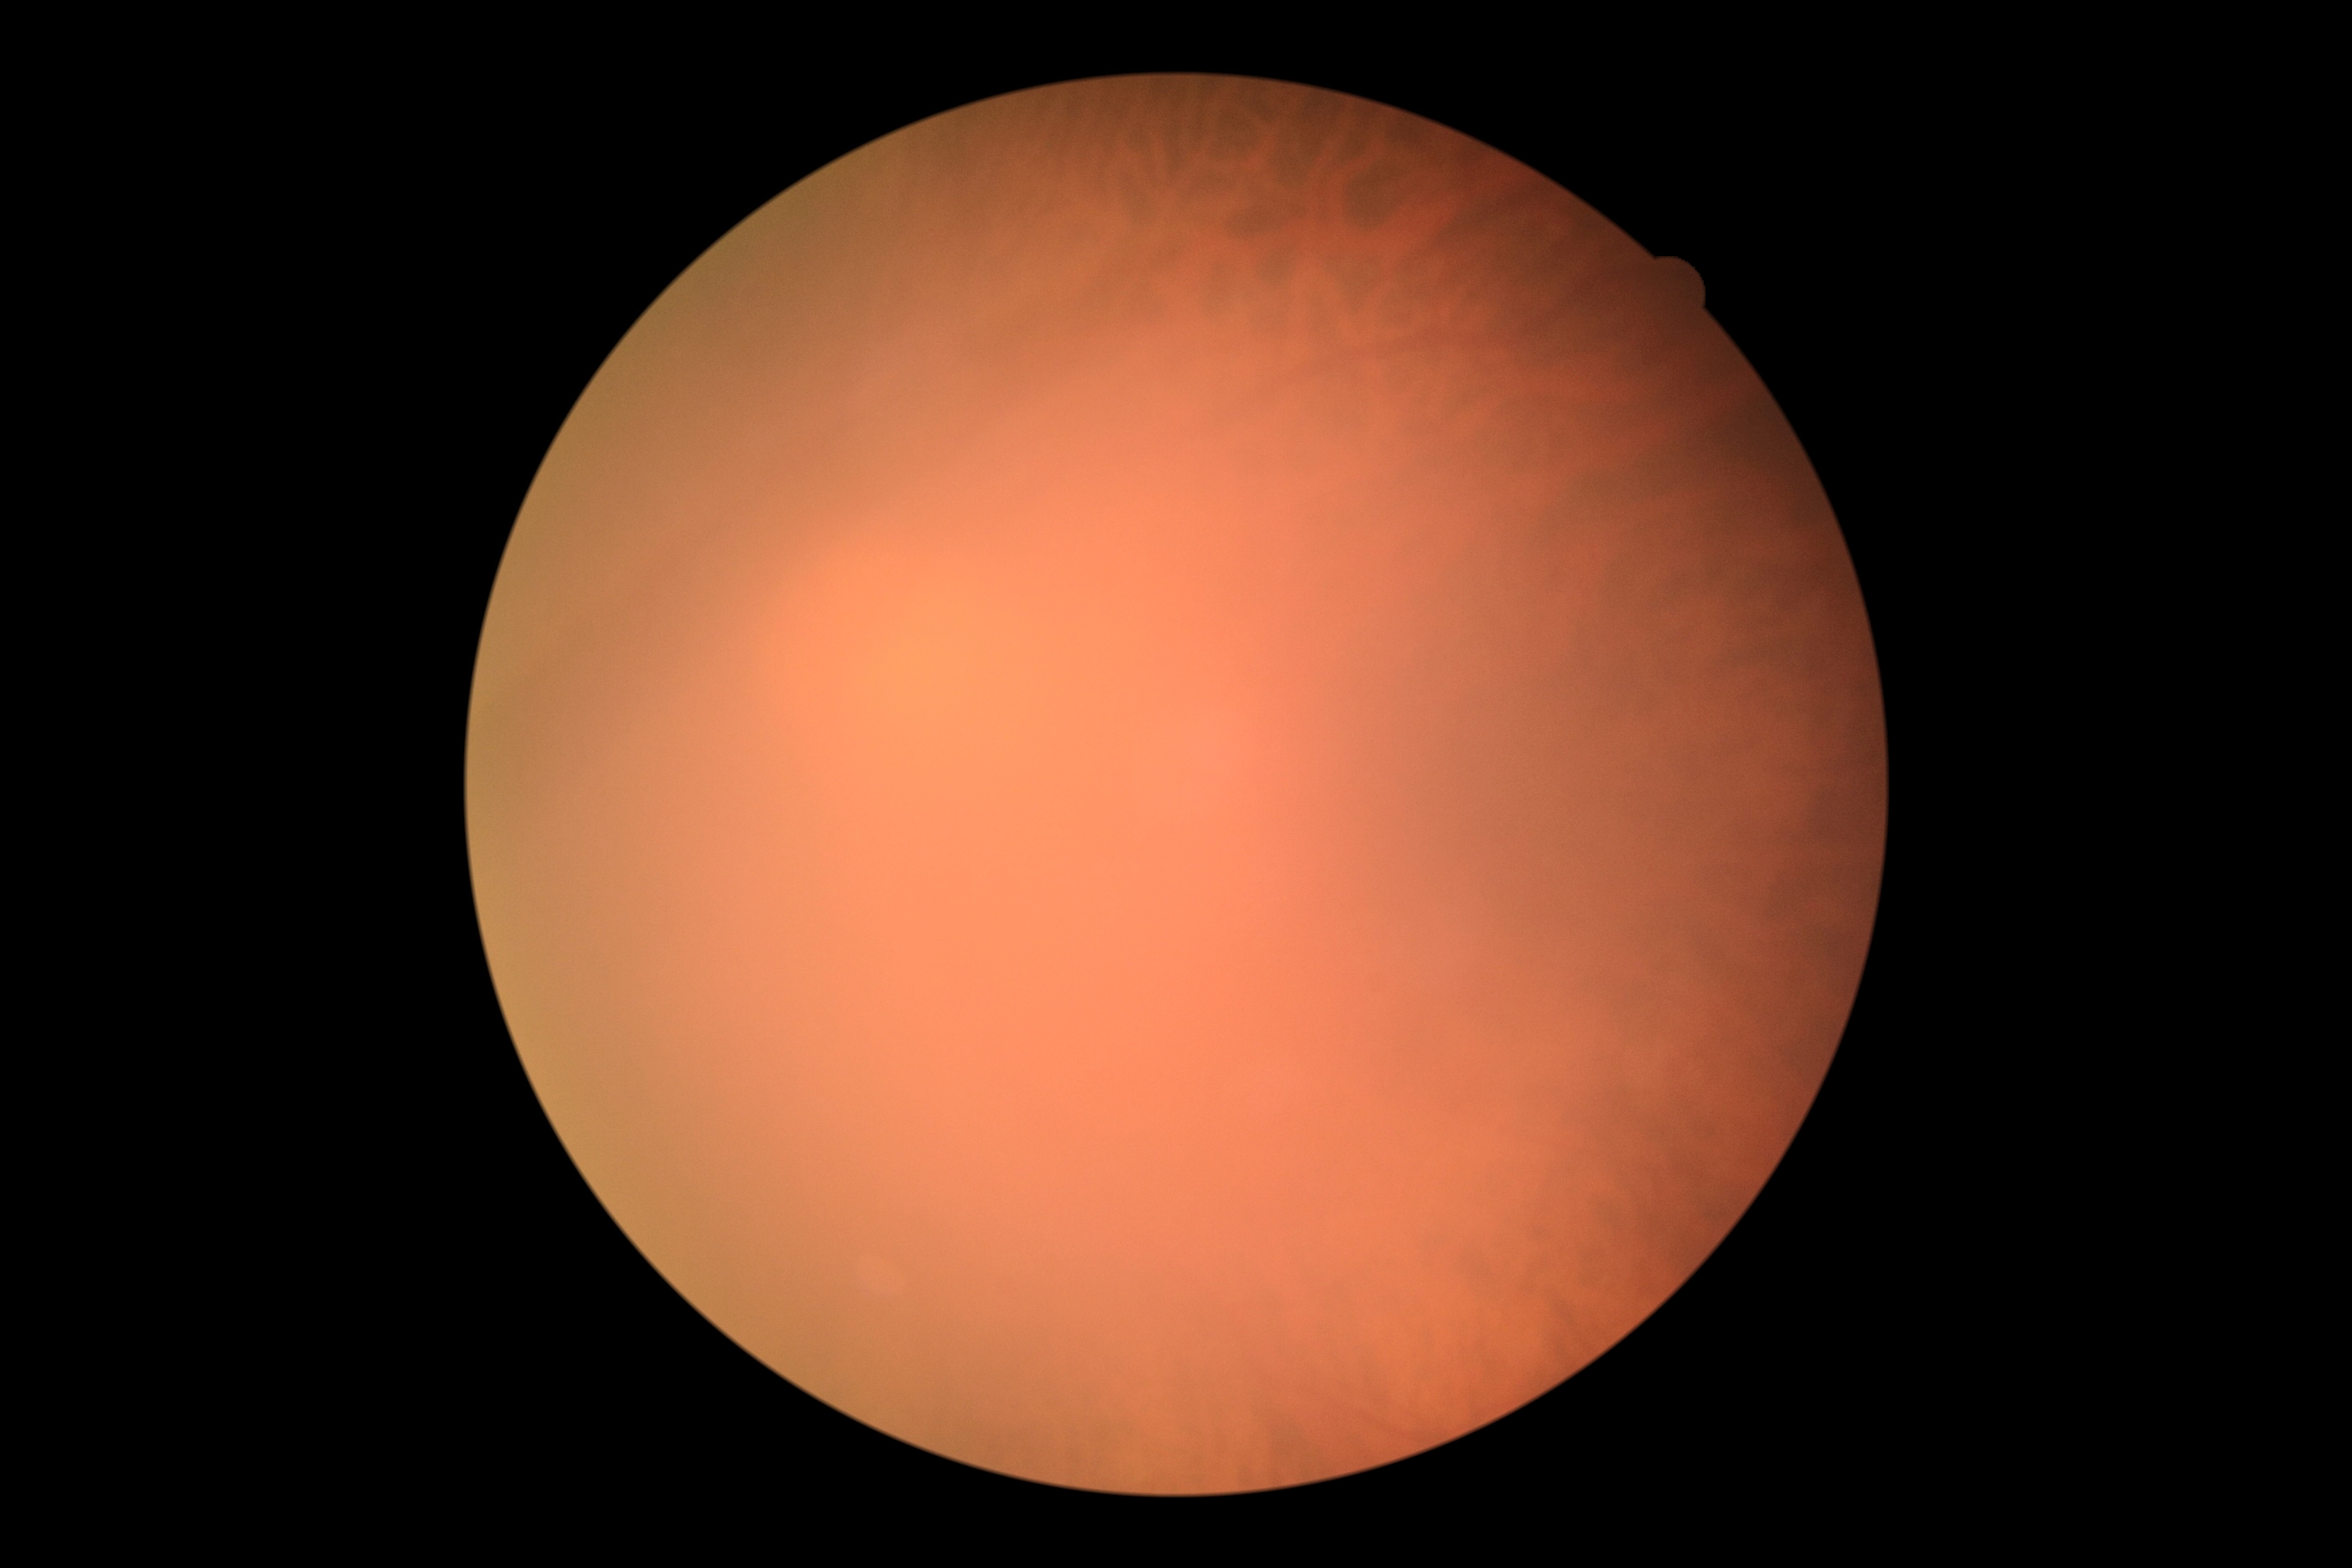

DR stage: ungradable due to poor image quality.
Ungradable image — DR severity cannot be determined.